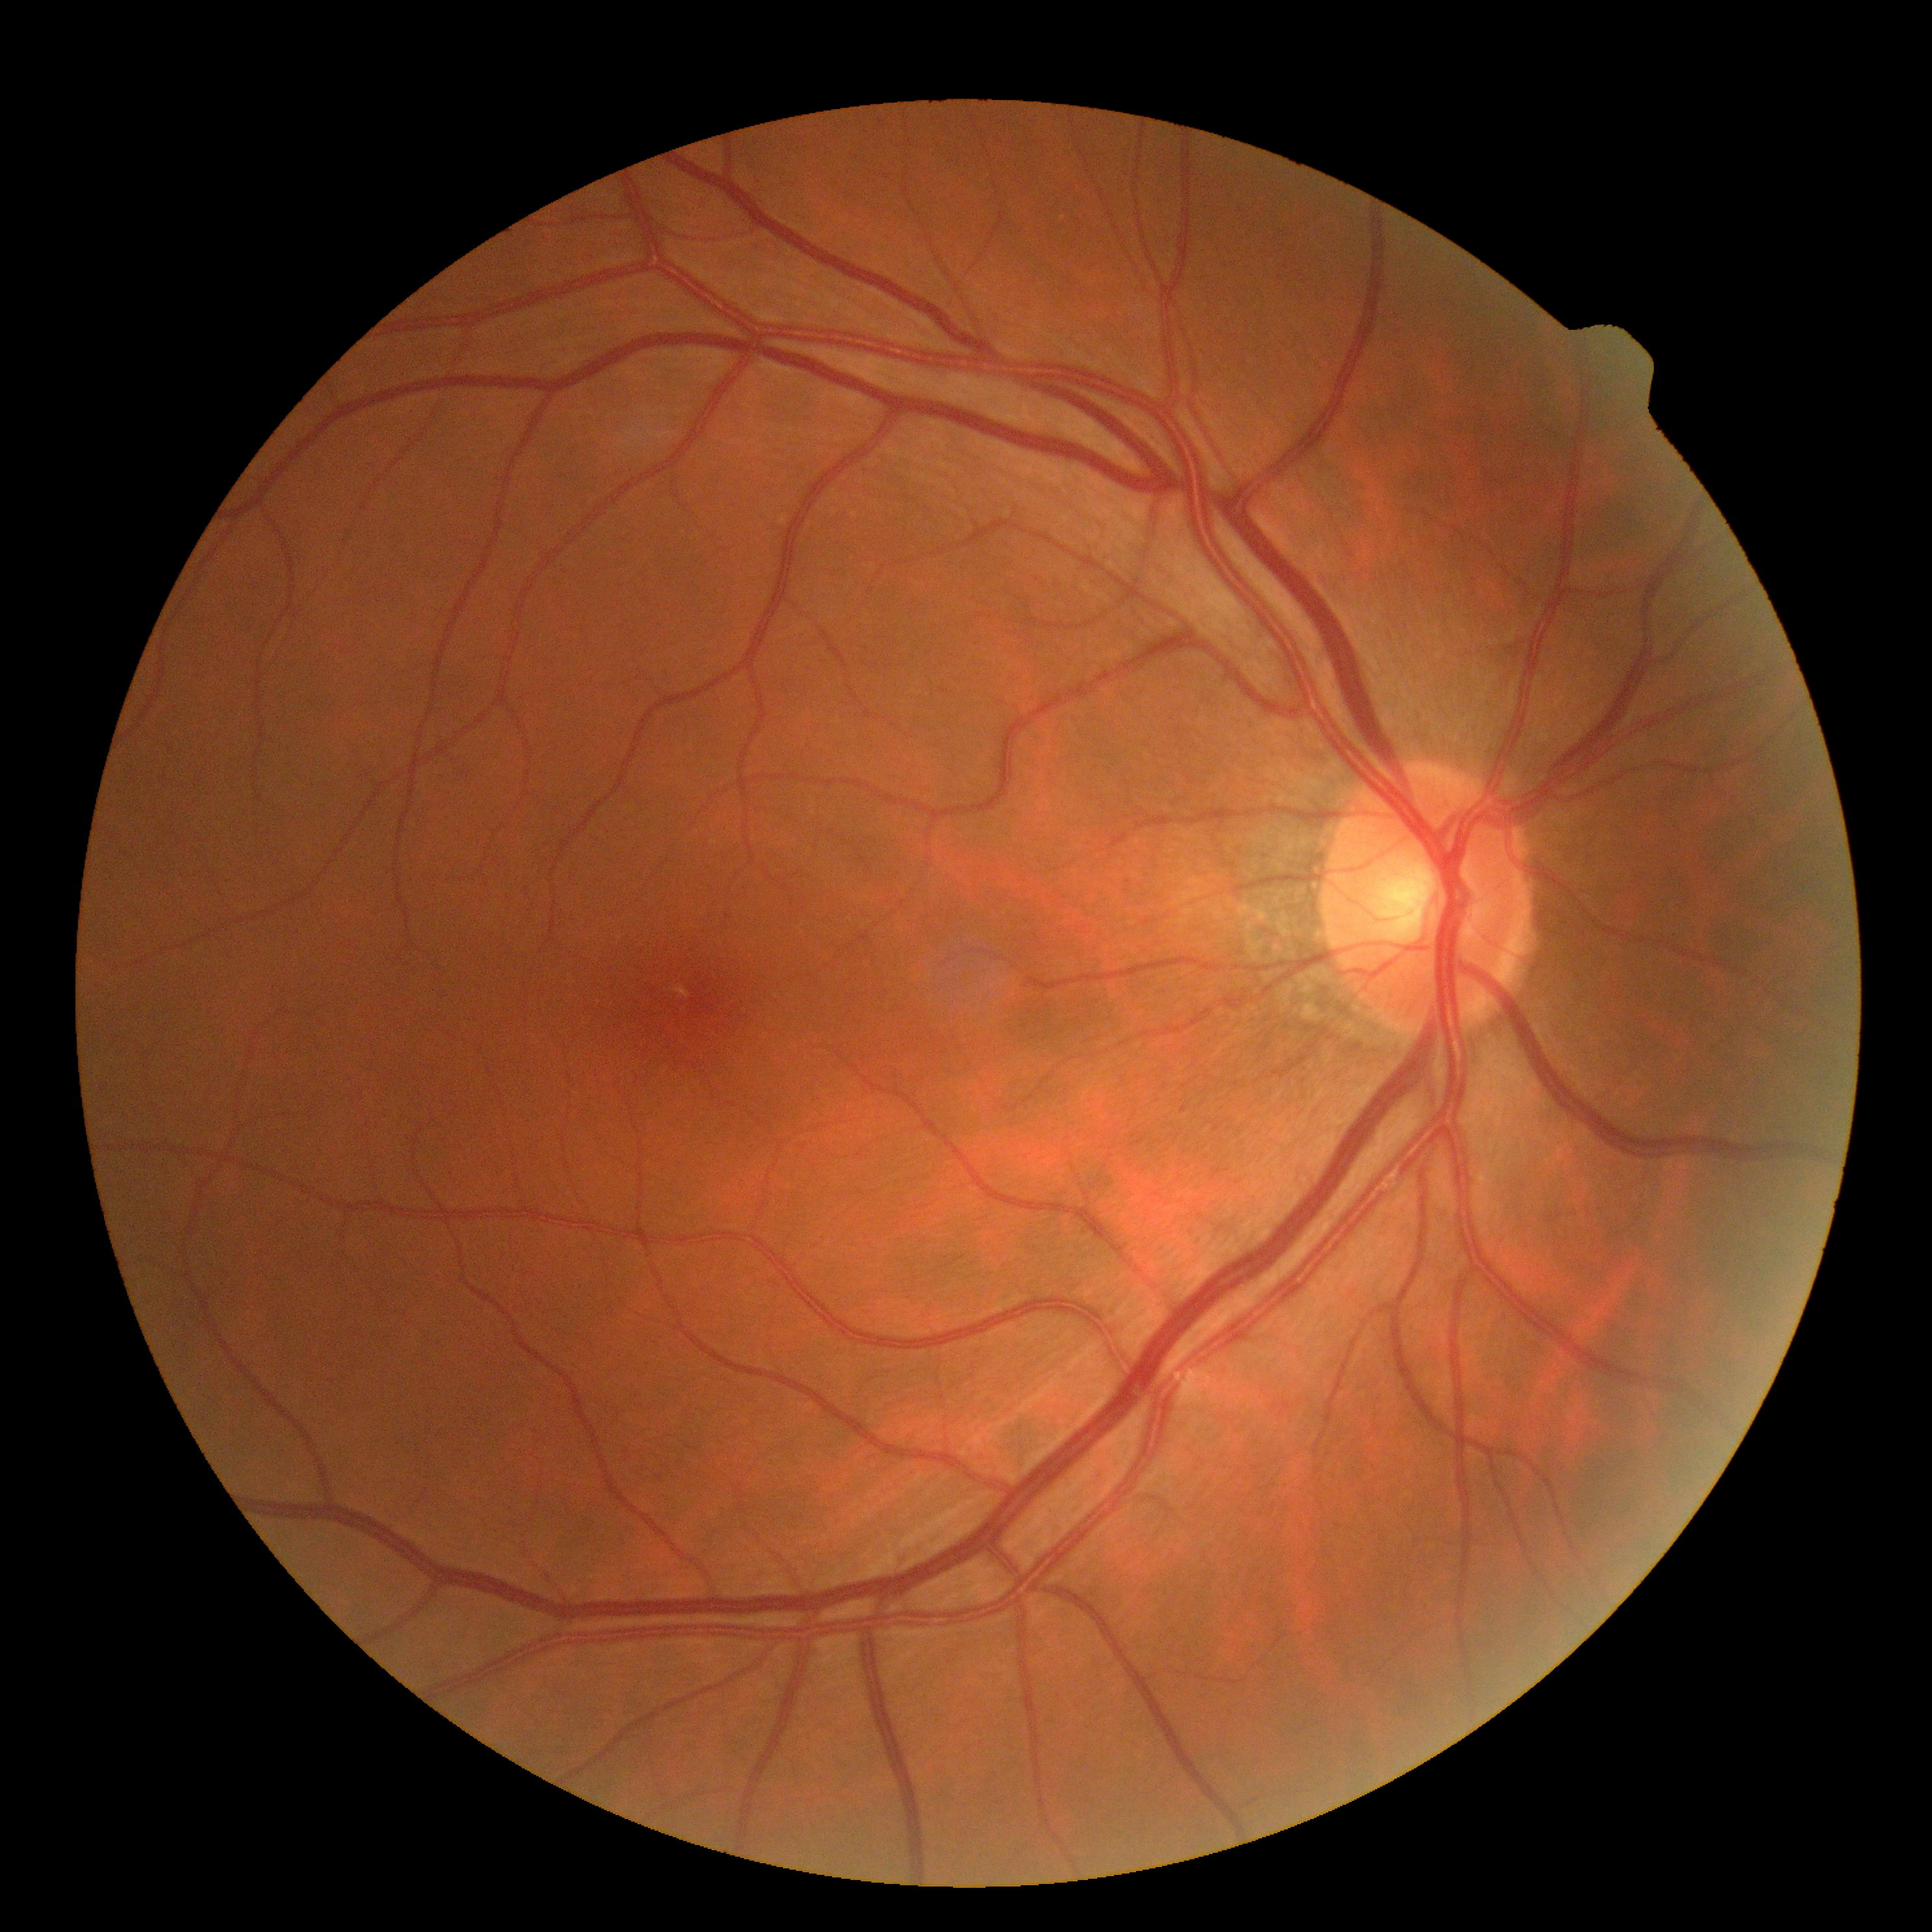
diabetic retinopathy severity = grade 0 (no apparent retinopathy)